Mydriatic (tropicamide phenylephrine 1.0%)
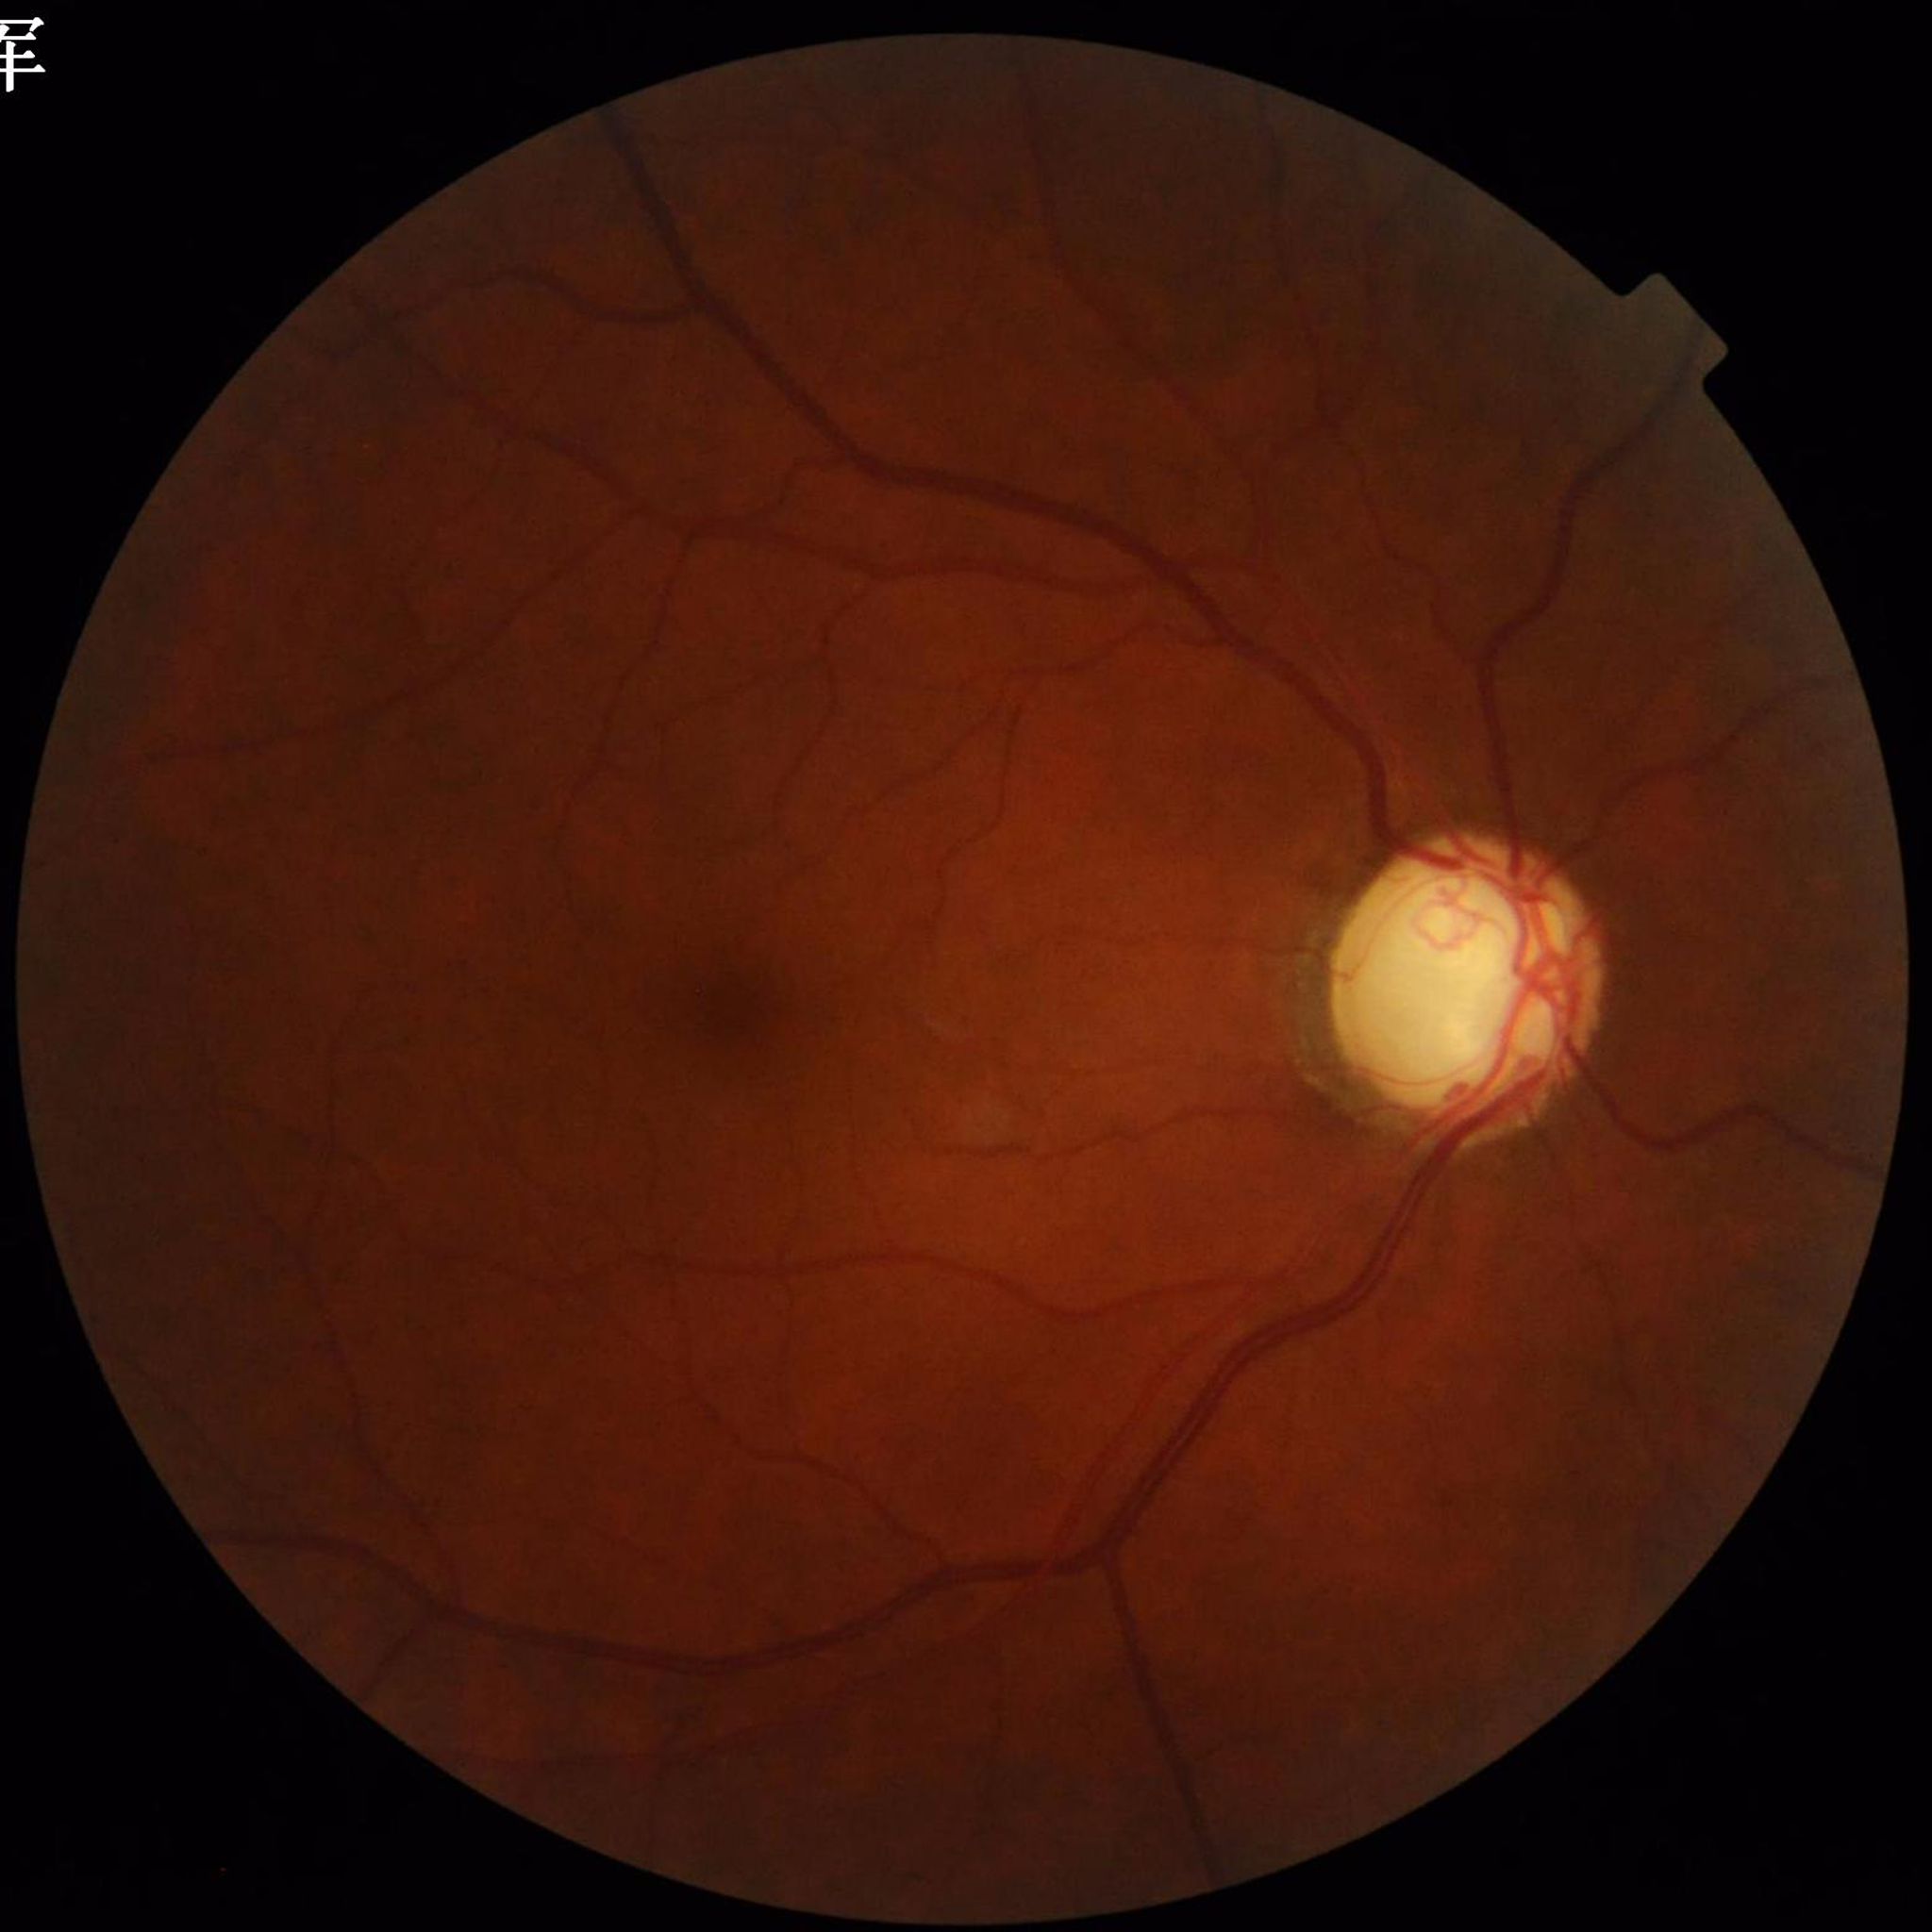

Retinal fundus photograph from a patient with glaucoma.